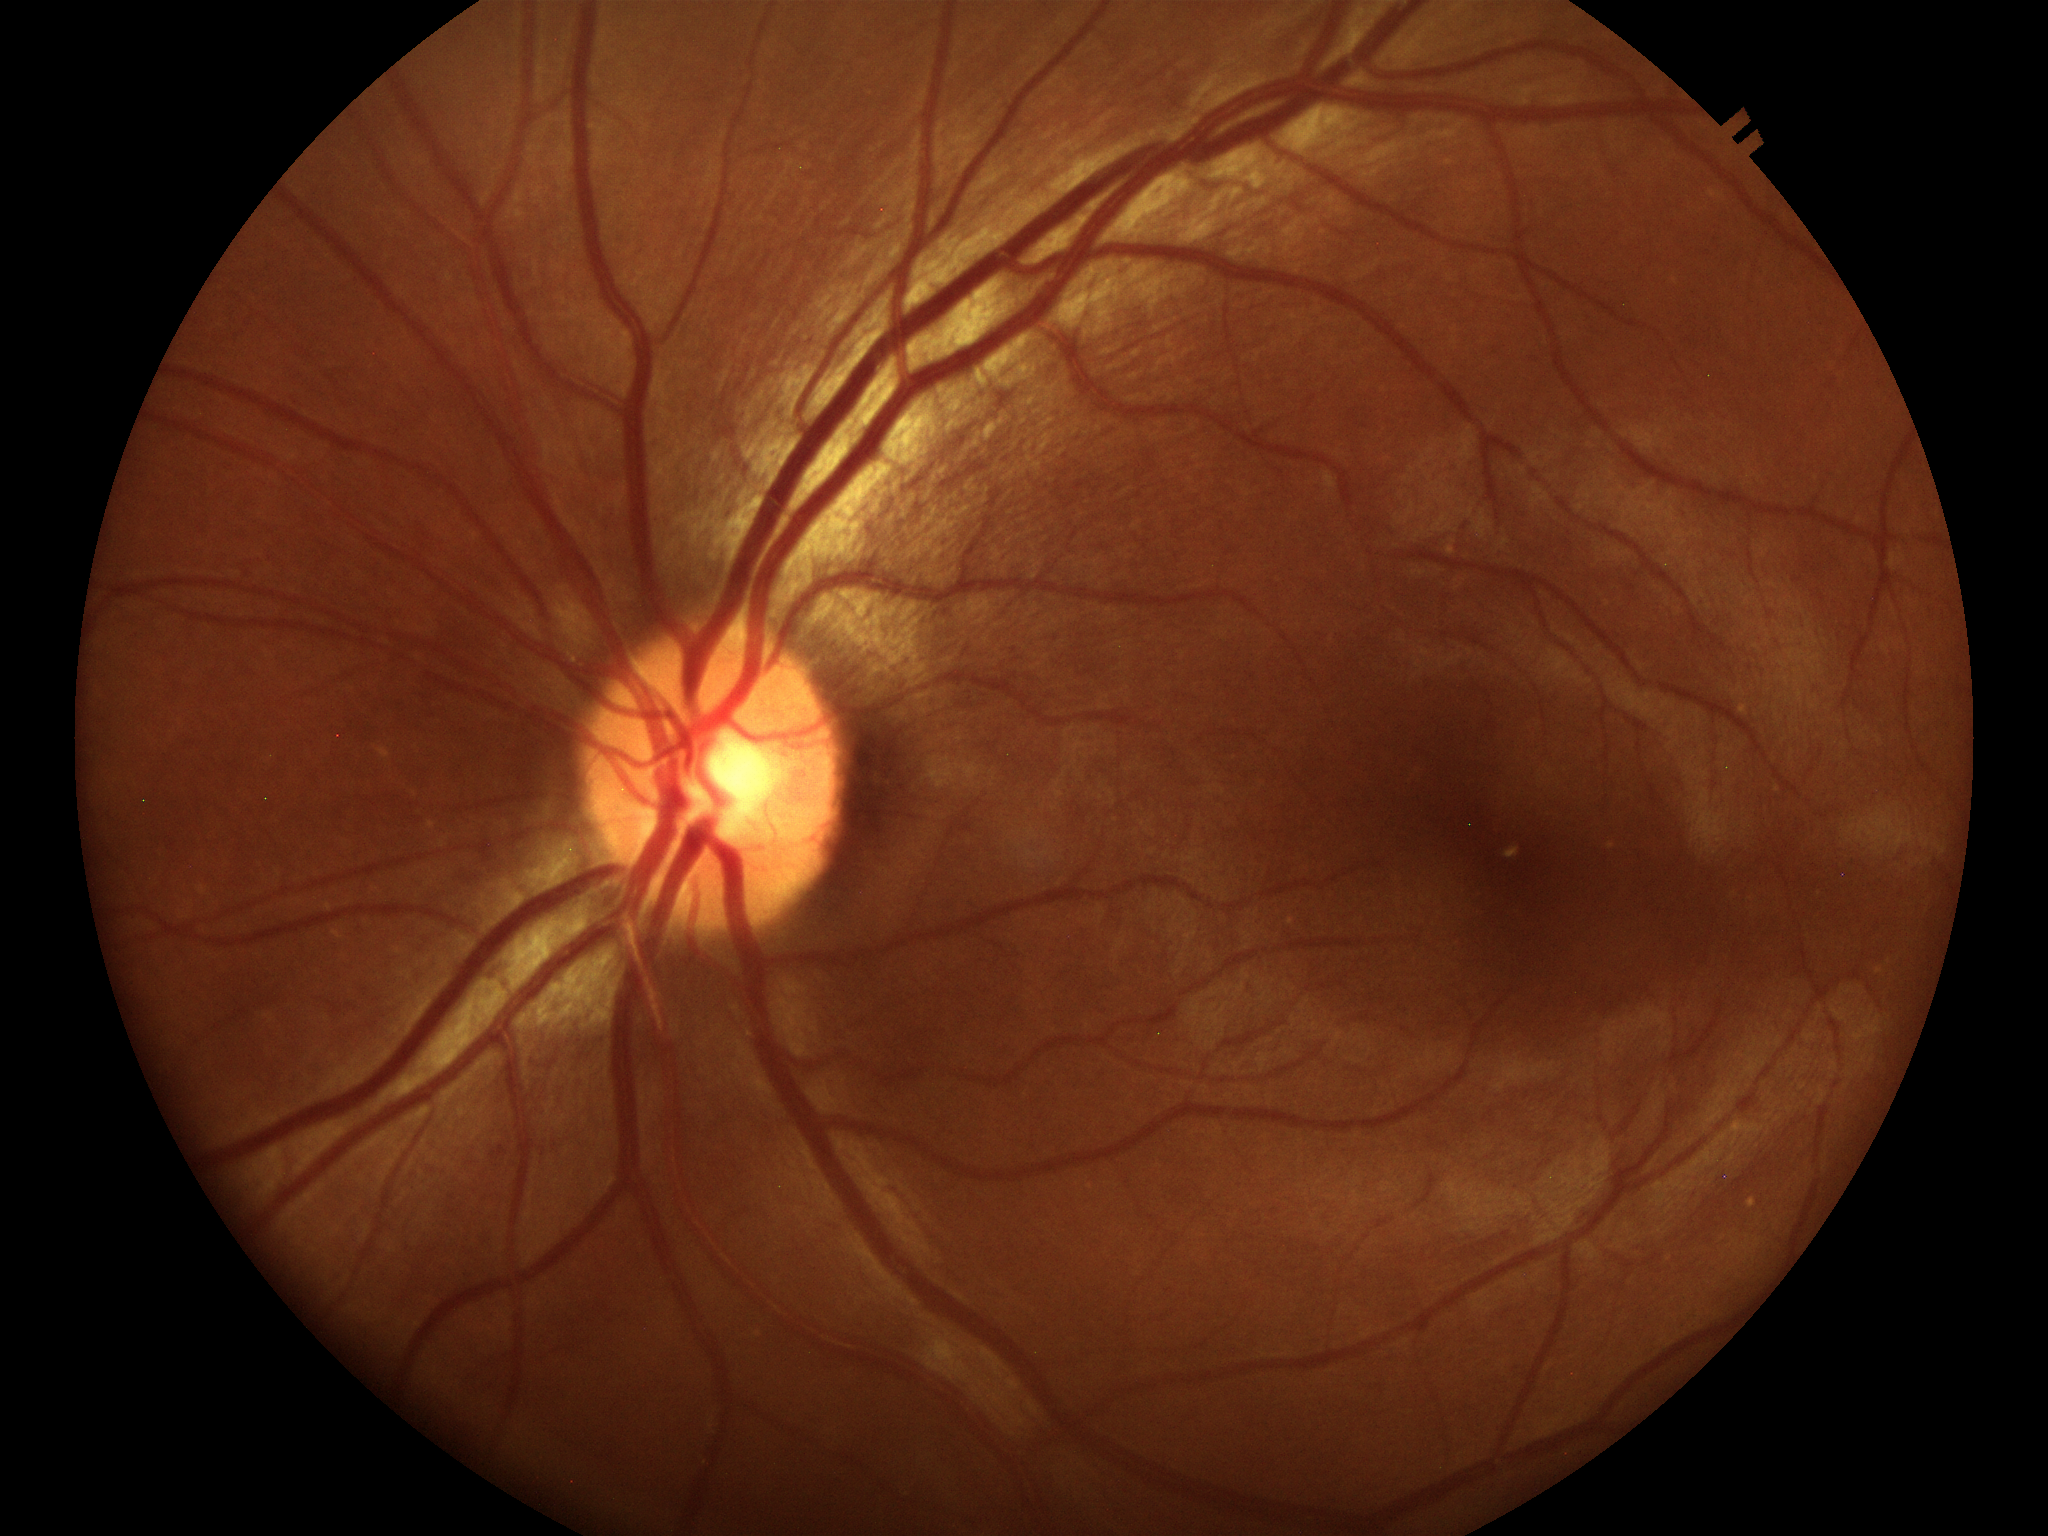
Vertical C/D ratio is 0.41.
Glaucoma screening impression: not suspect (all 5 graders called normal).